Wide-field fundus photograph of an infant · 1240x1240 · 100° field of view (Phoenix ICON)
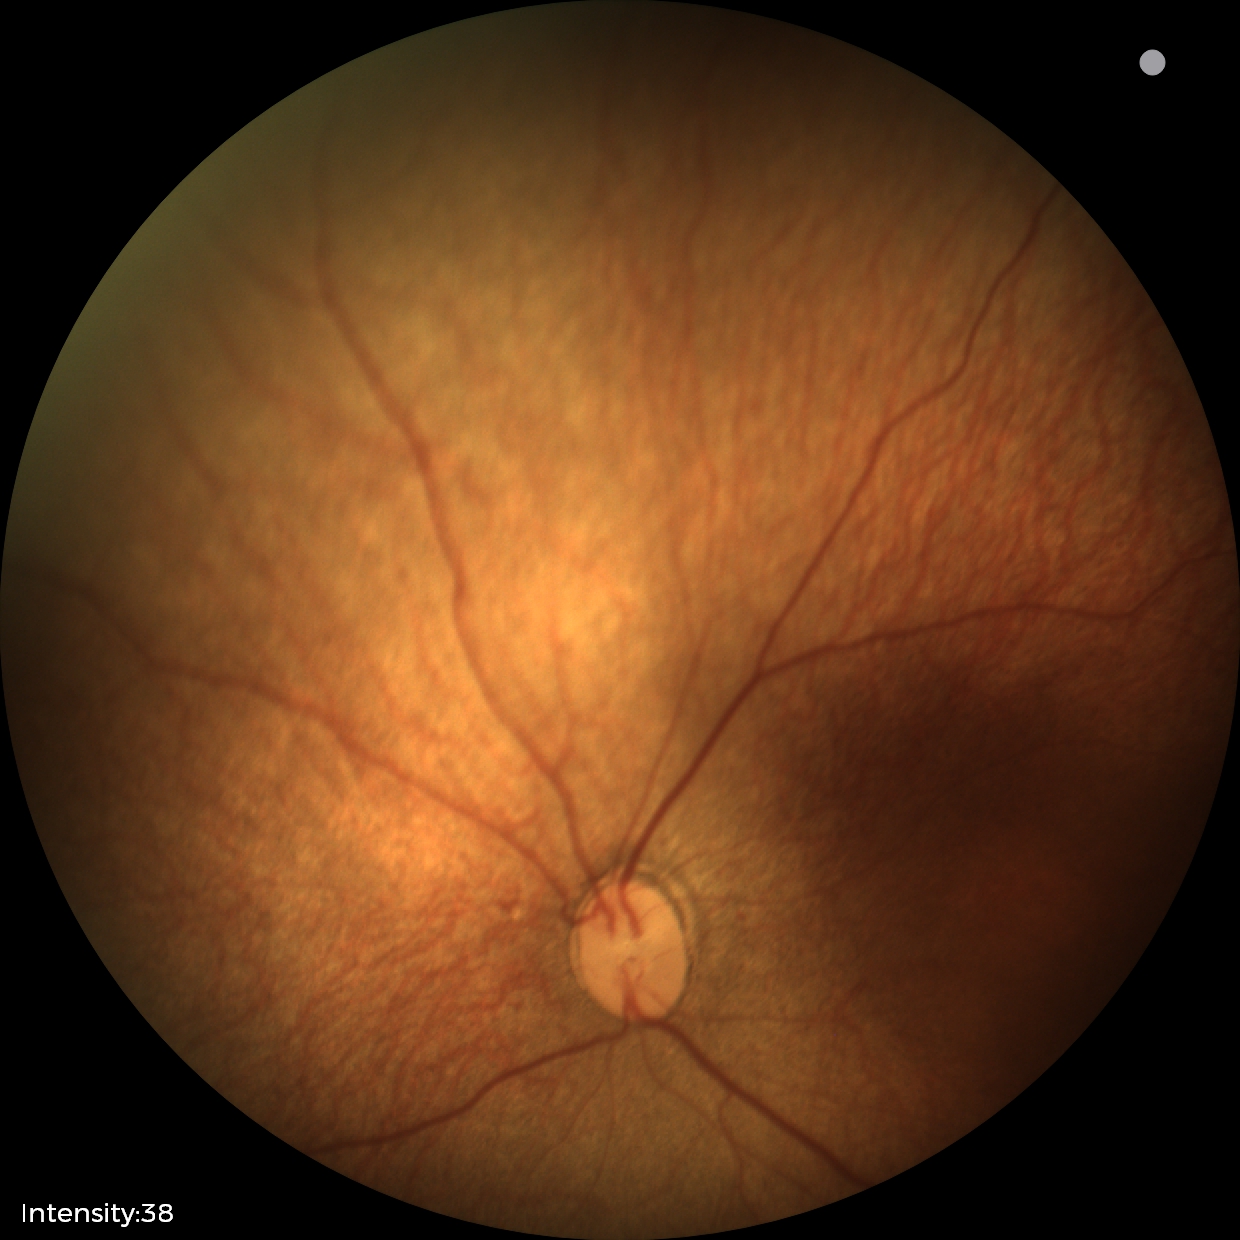
Plus form = absent — posterior pole vessels without abnormal dilation or tortuosity, impression = status post ROP.